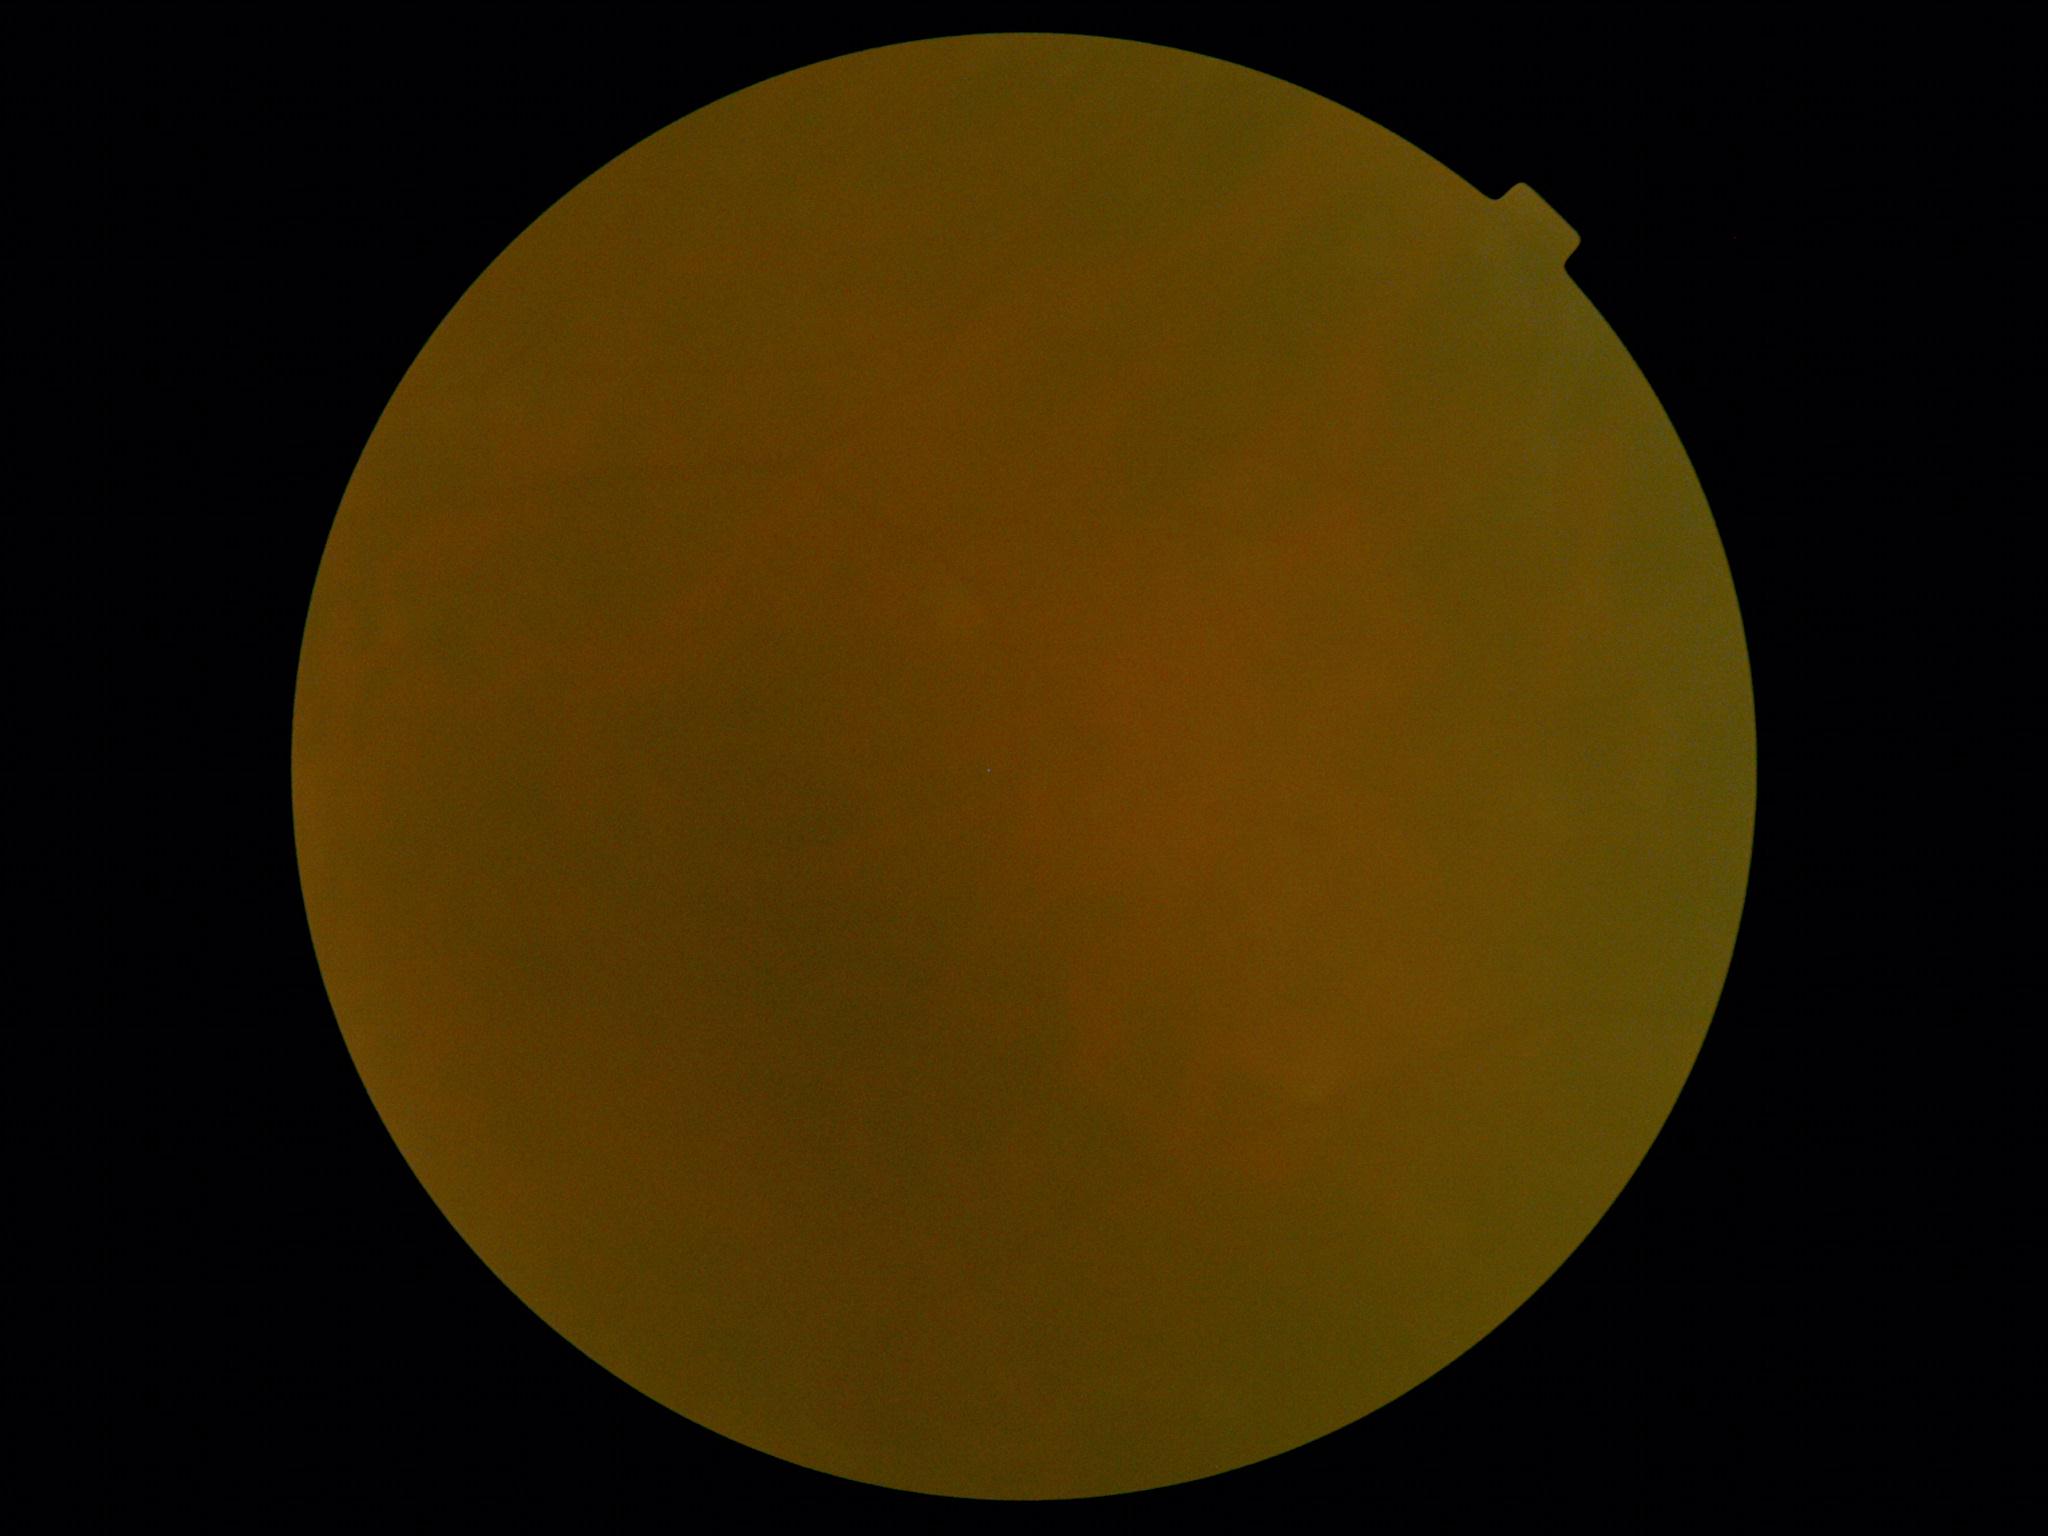

Retinopathy is ungradable due to poor image quality.
The image cannot be graded for diabetic retinopathy.